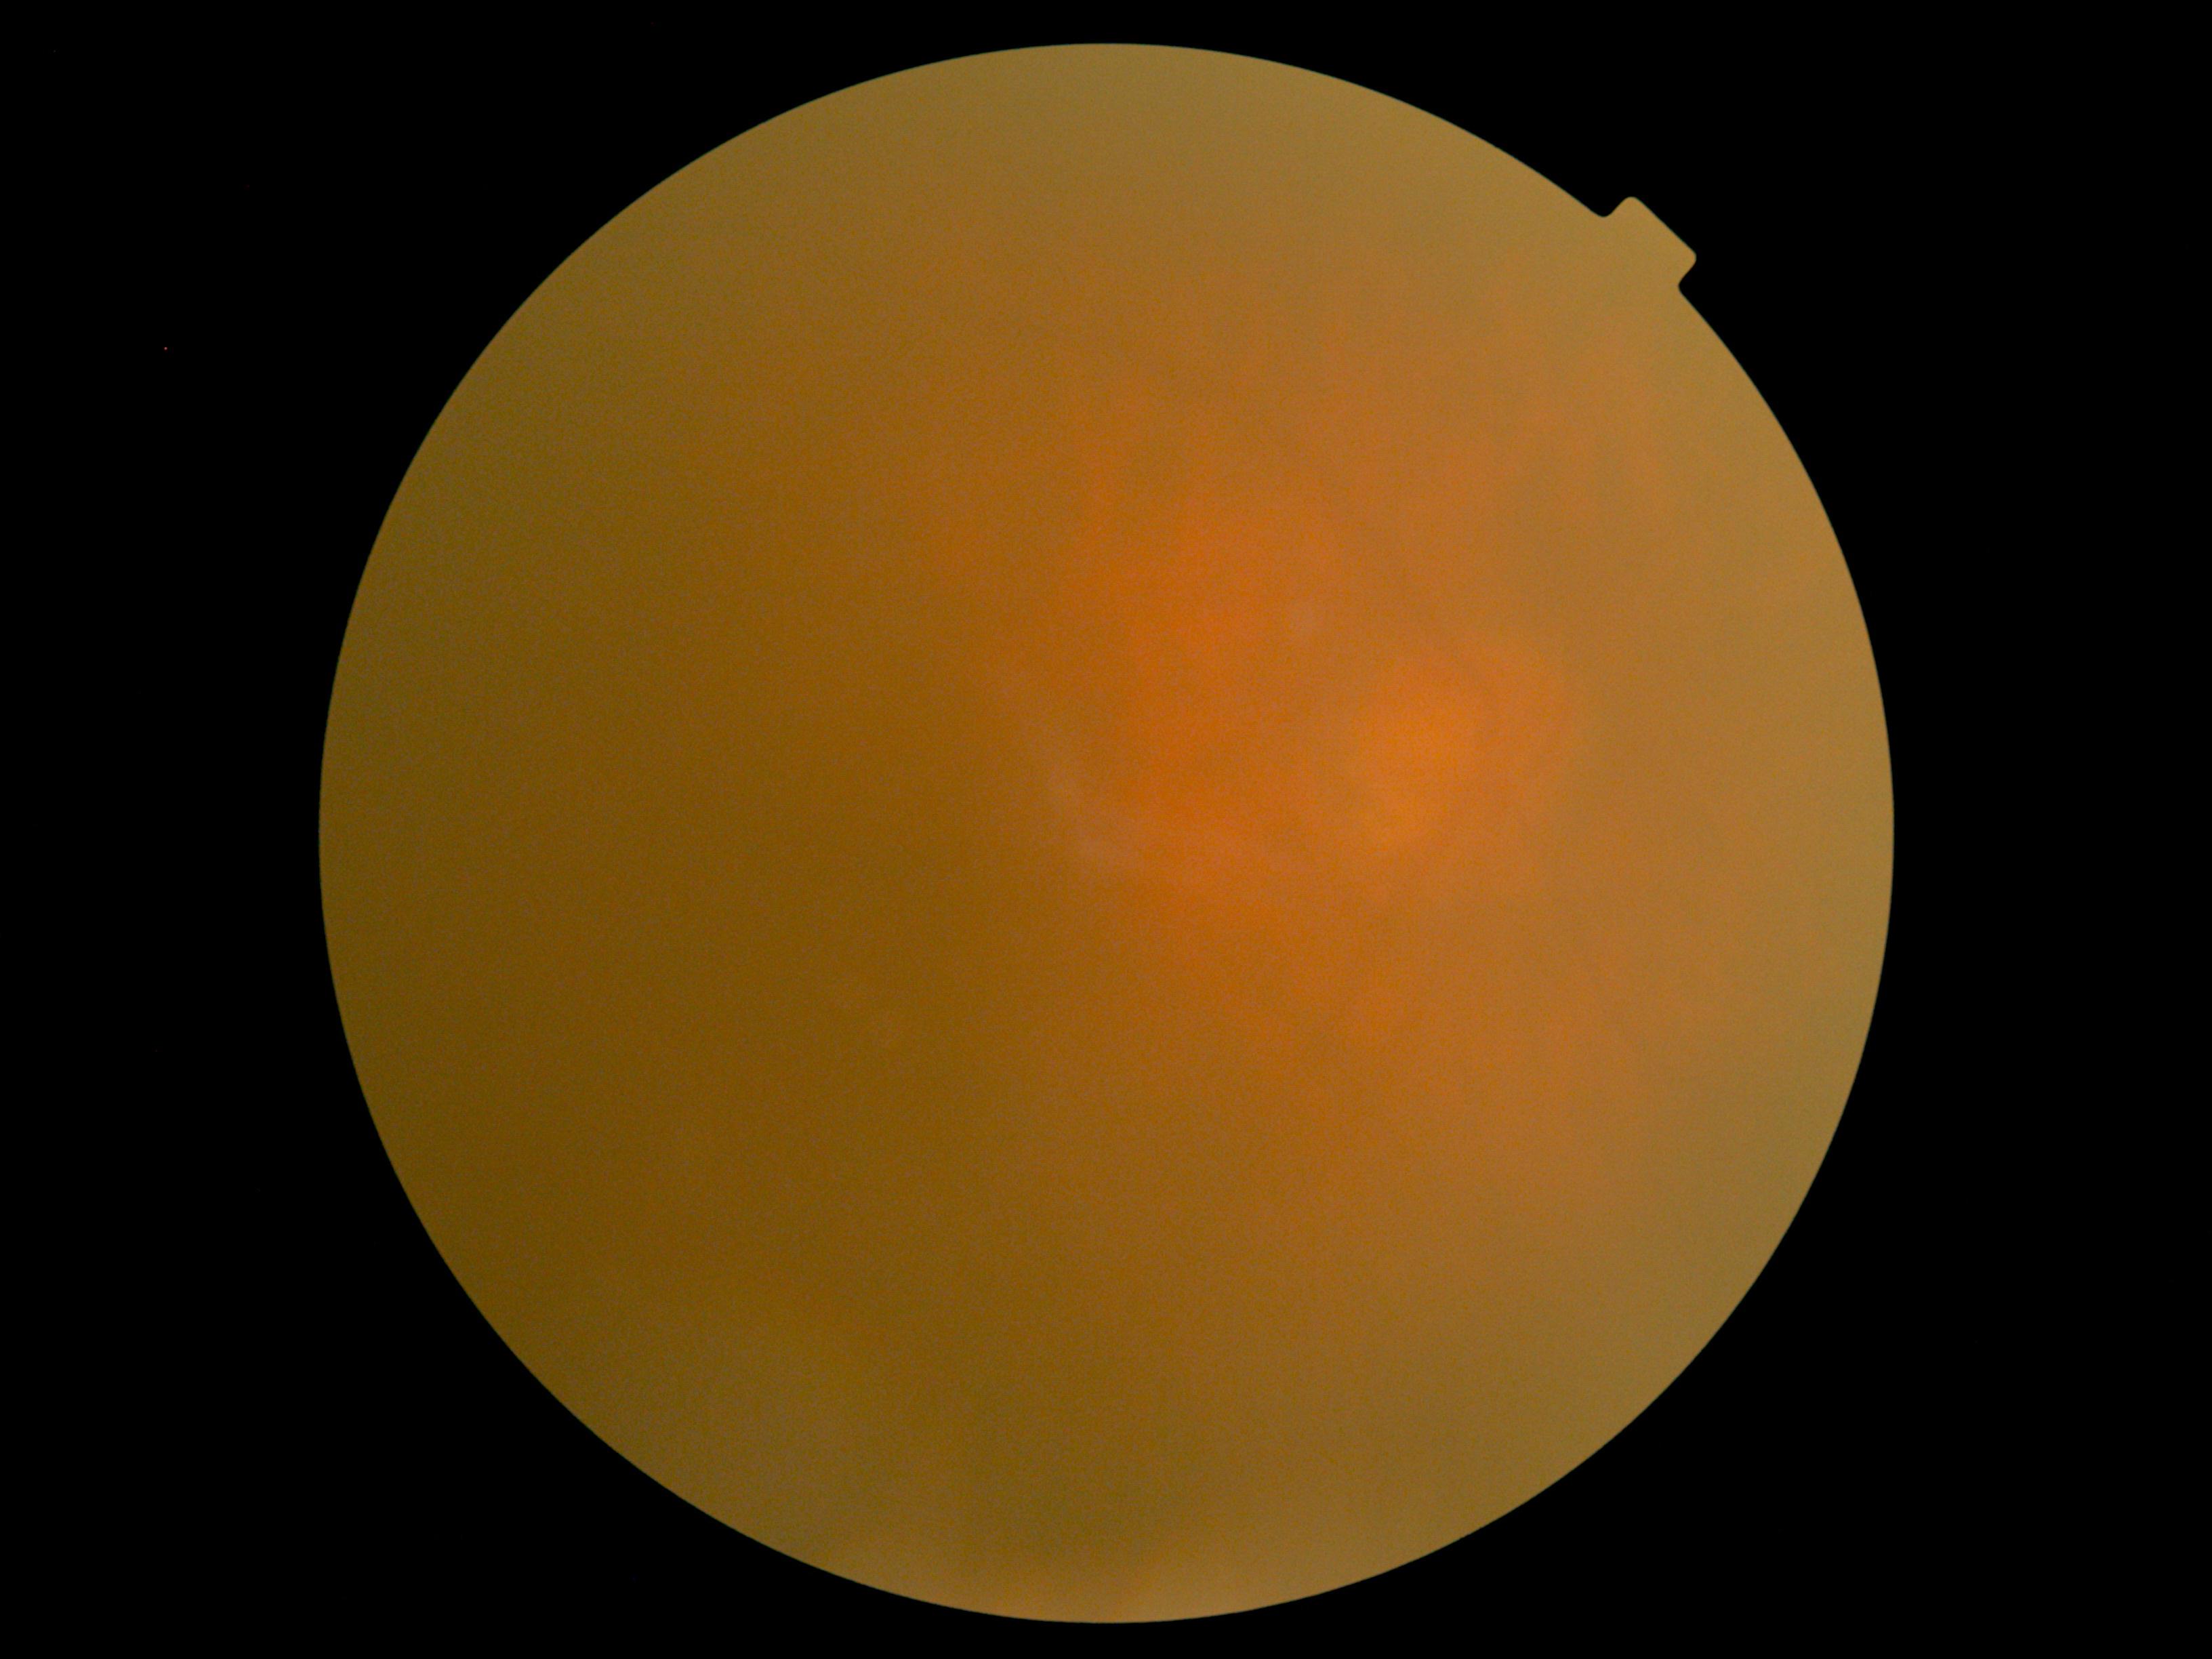

DR severity is ungradable due to poor image quality.
Quality too poor to assess for DR.